Infant wide-field retinal image: 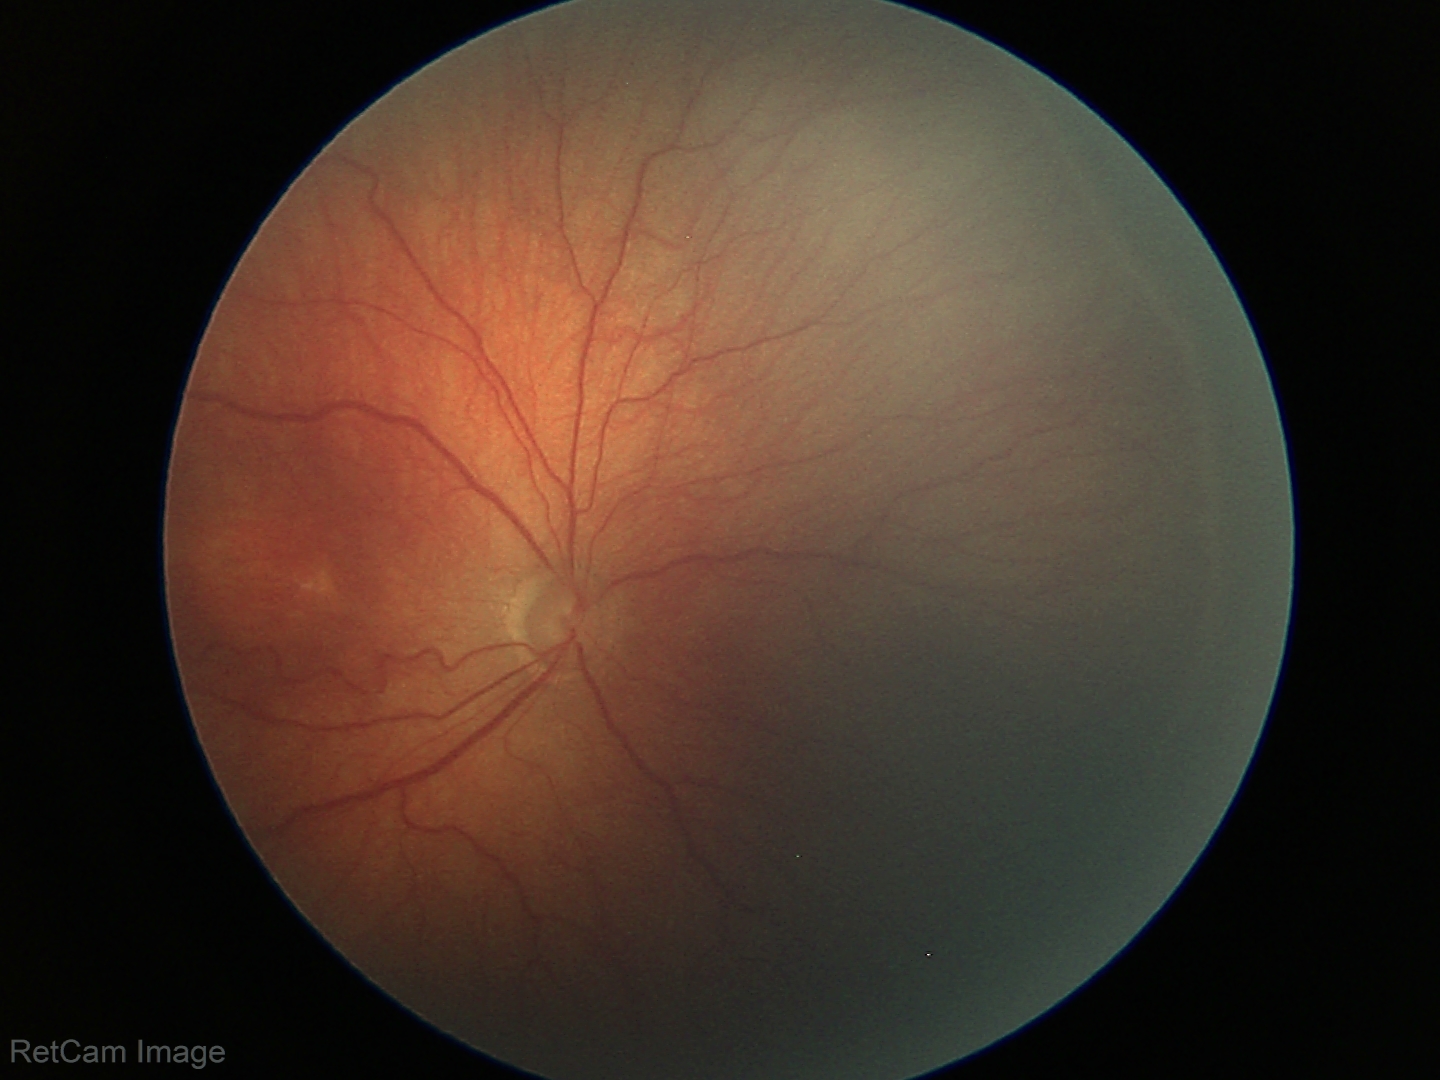 Screening examination consistent with ROP stage 3.